DR severity per modified Davis staging
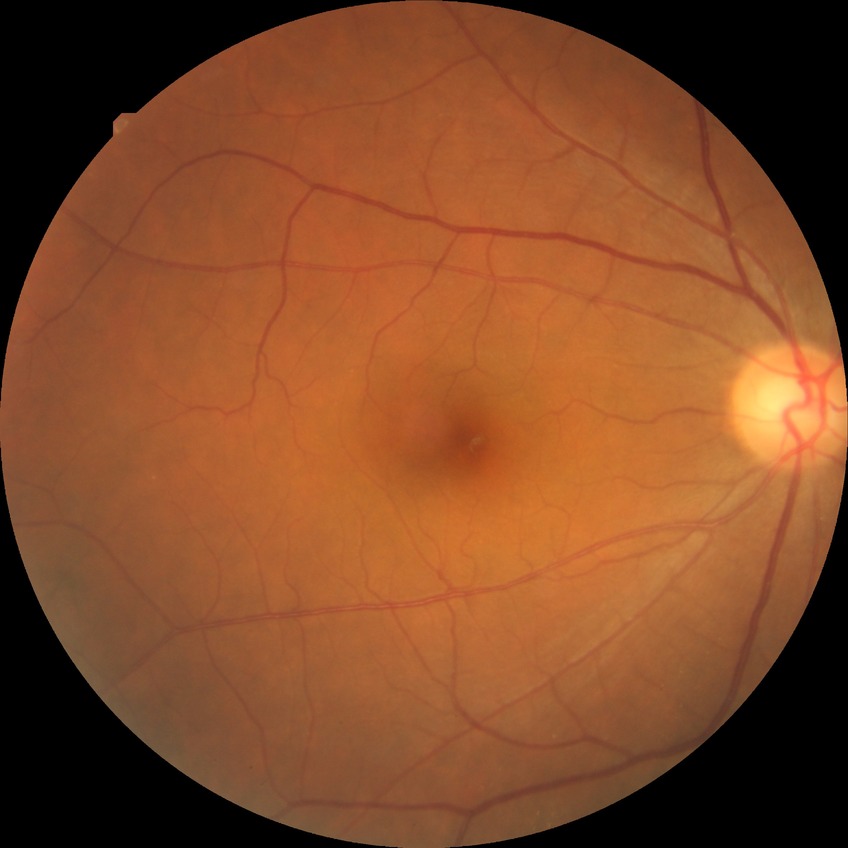 No diabetic retinal disease findings. DR grade is NDR.